2212x1659px. 45° FOV — 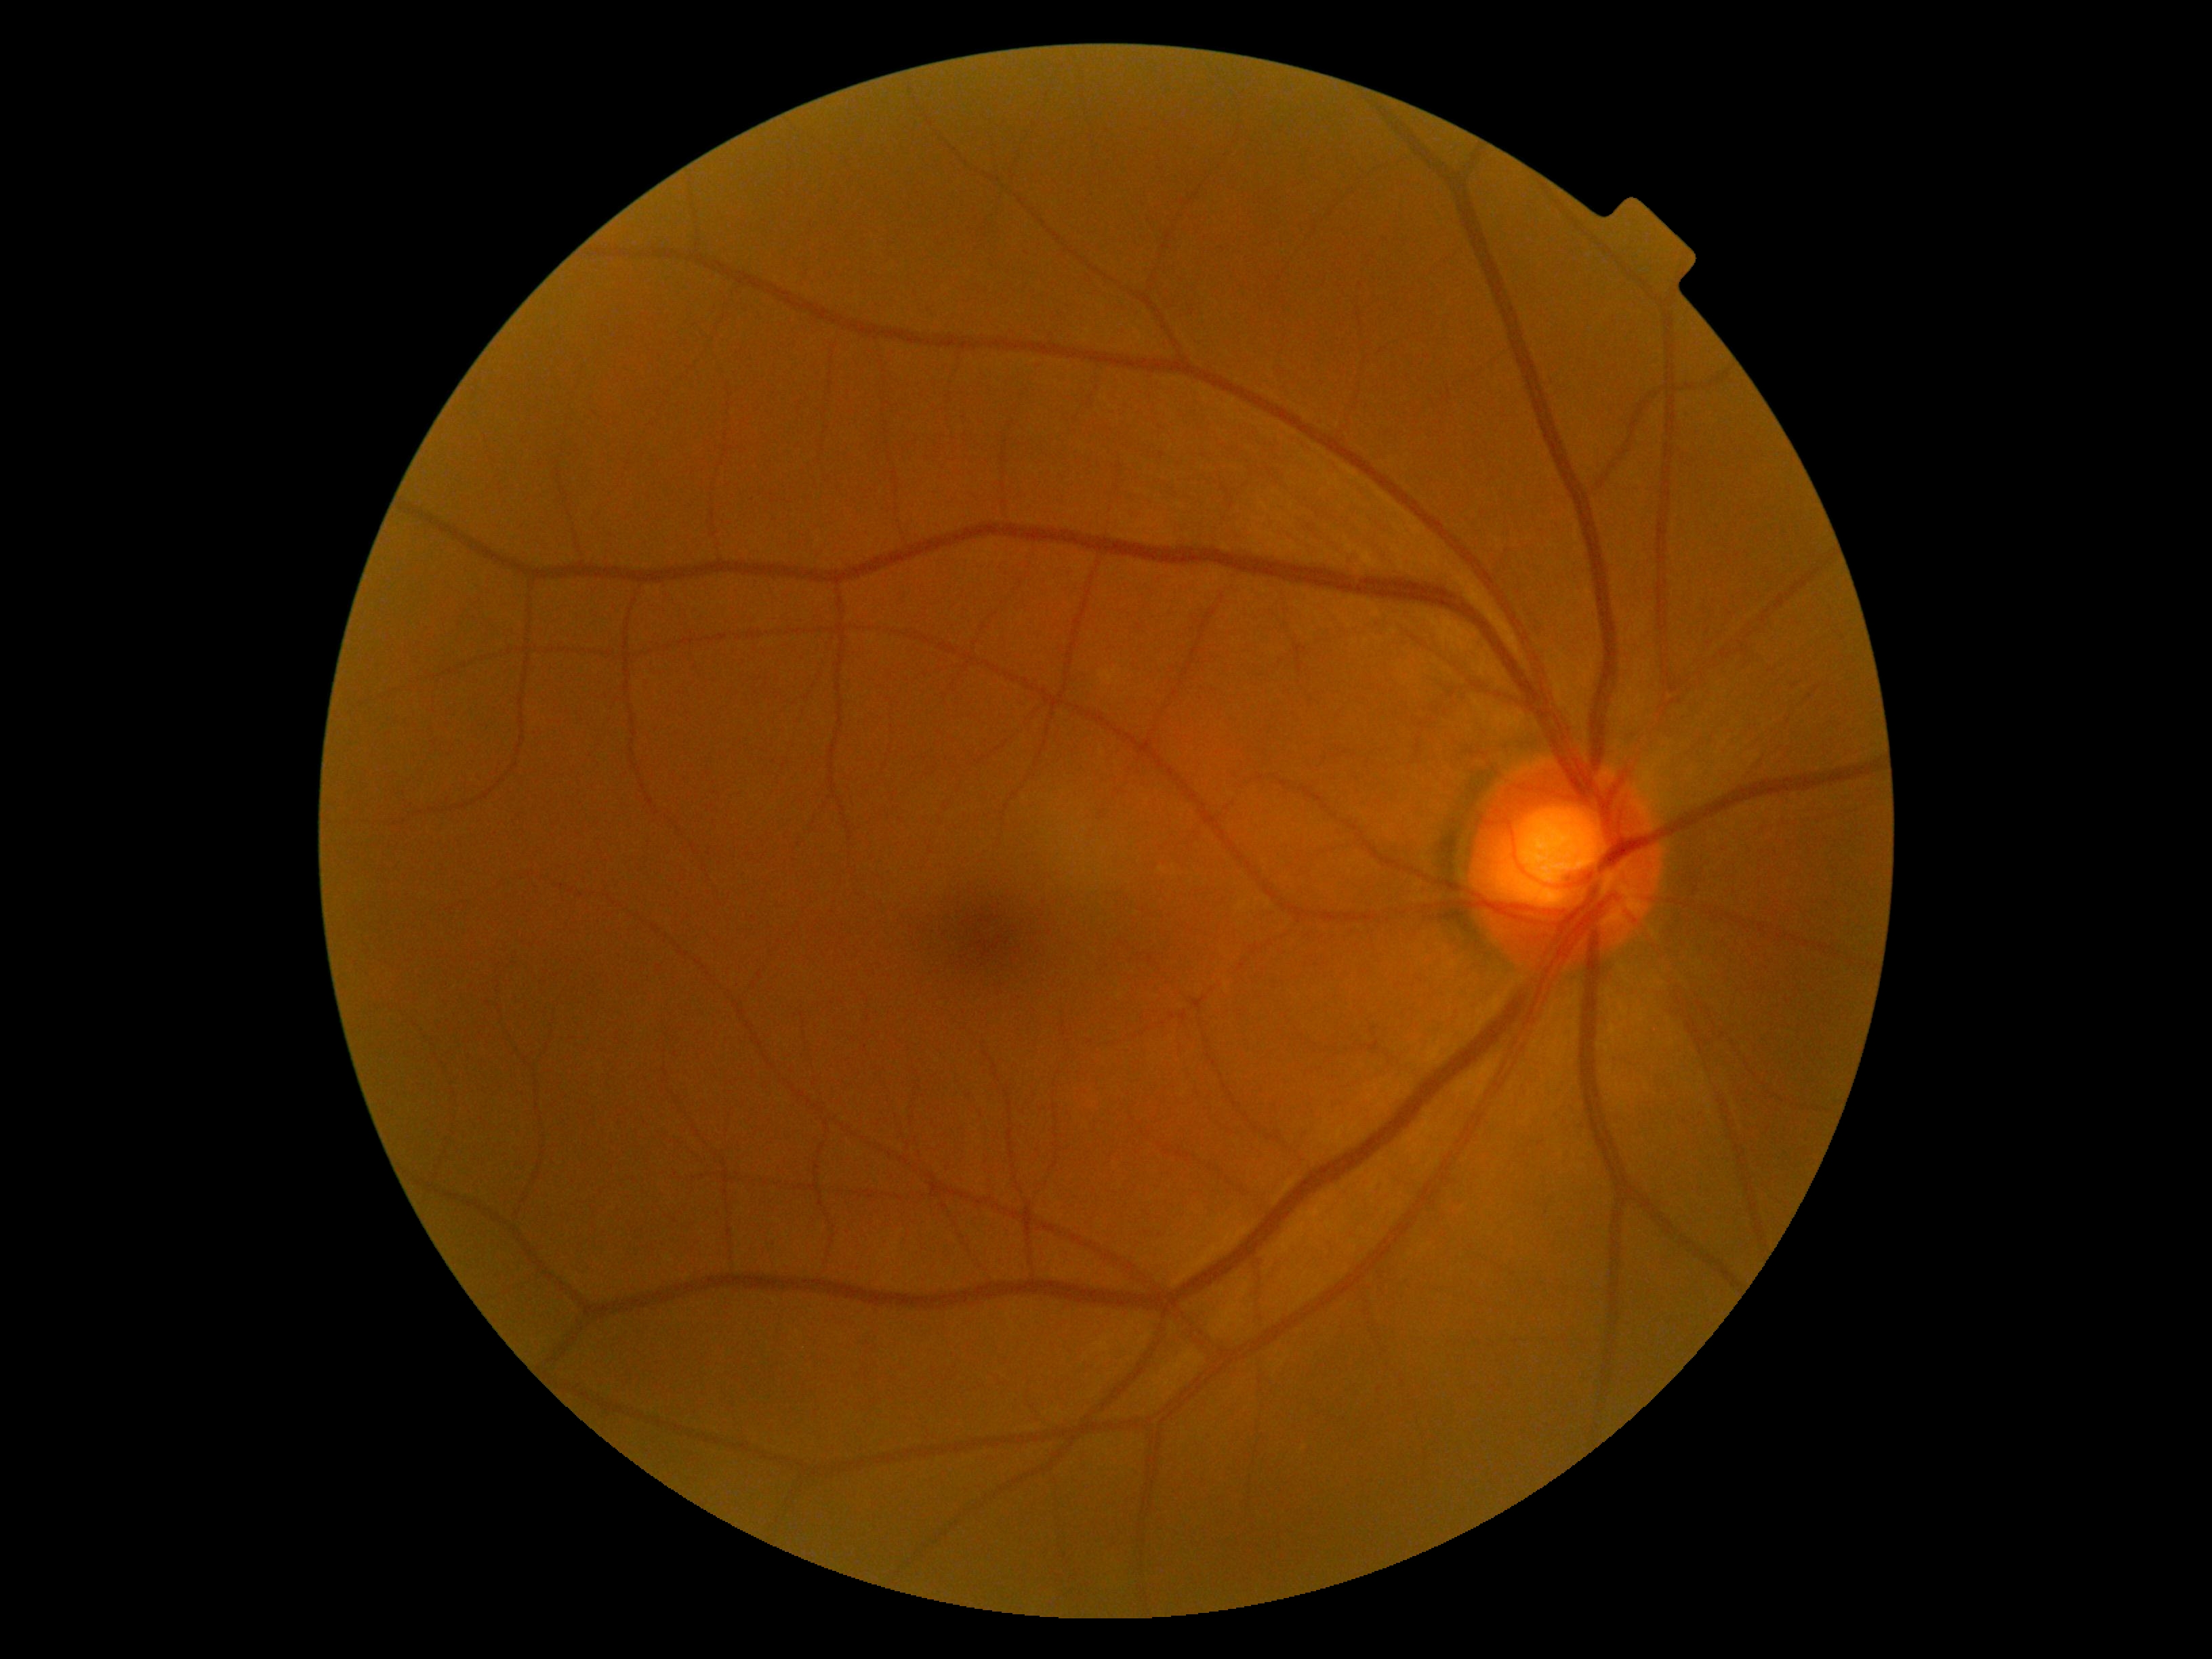 dr_grade: 0